2212 x 1659 pixels, color fundus photograph.
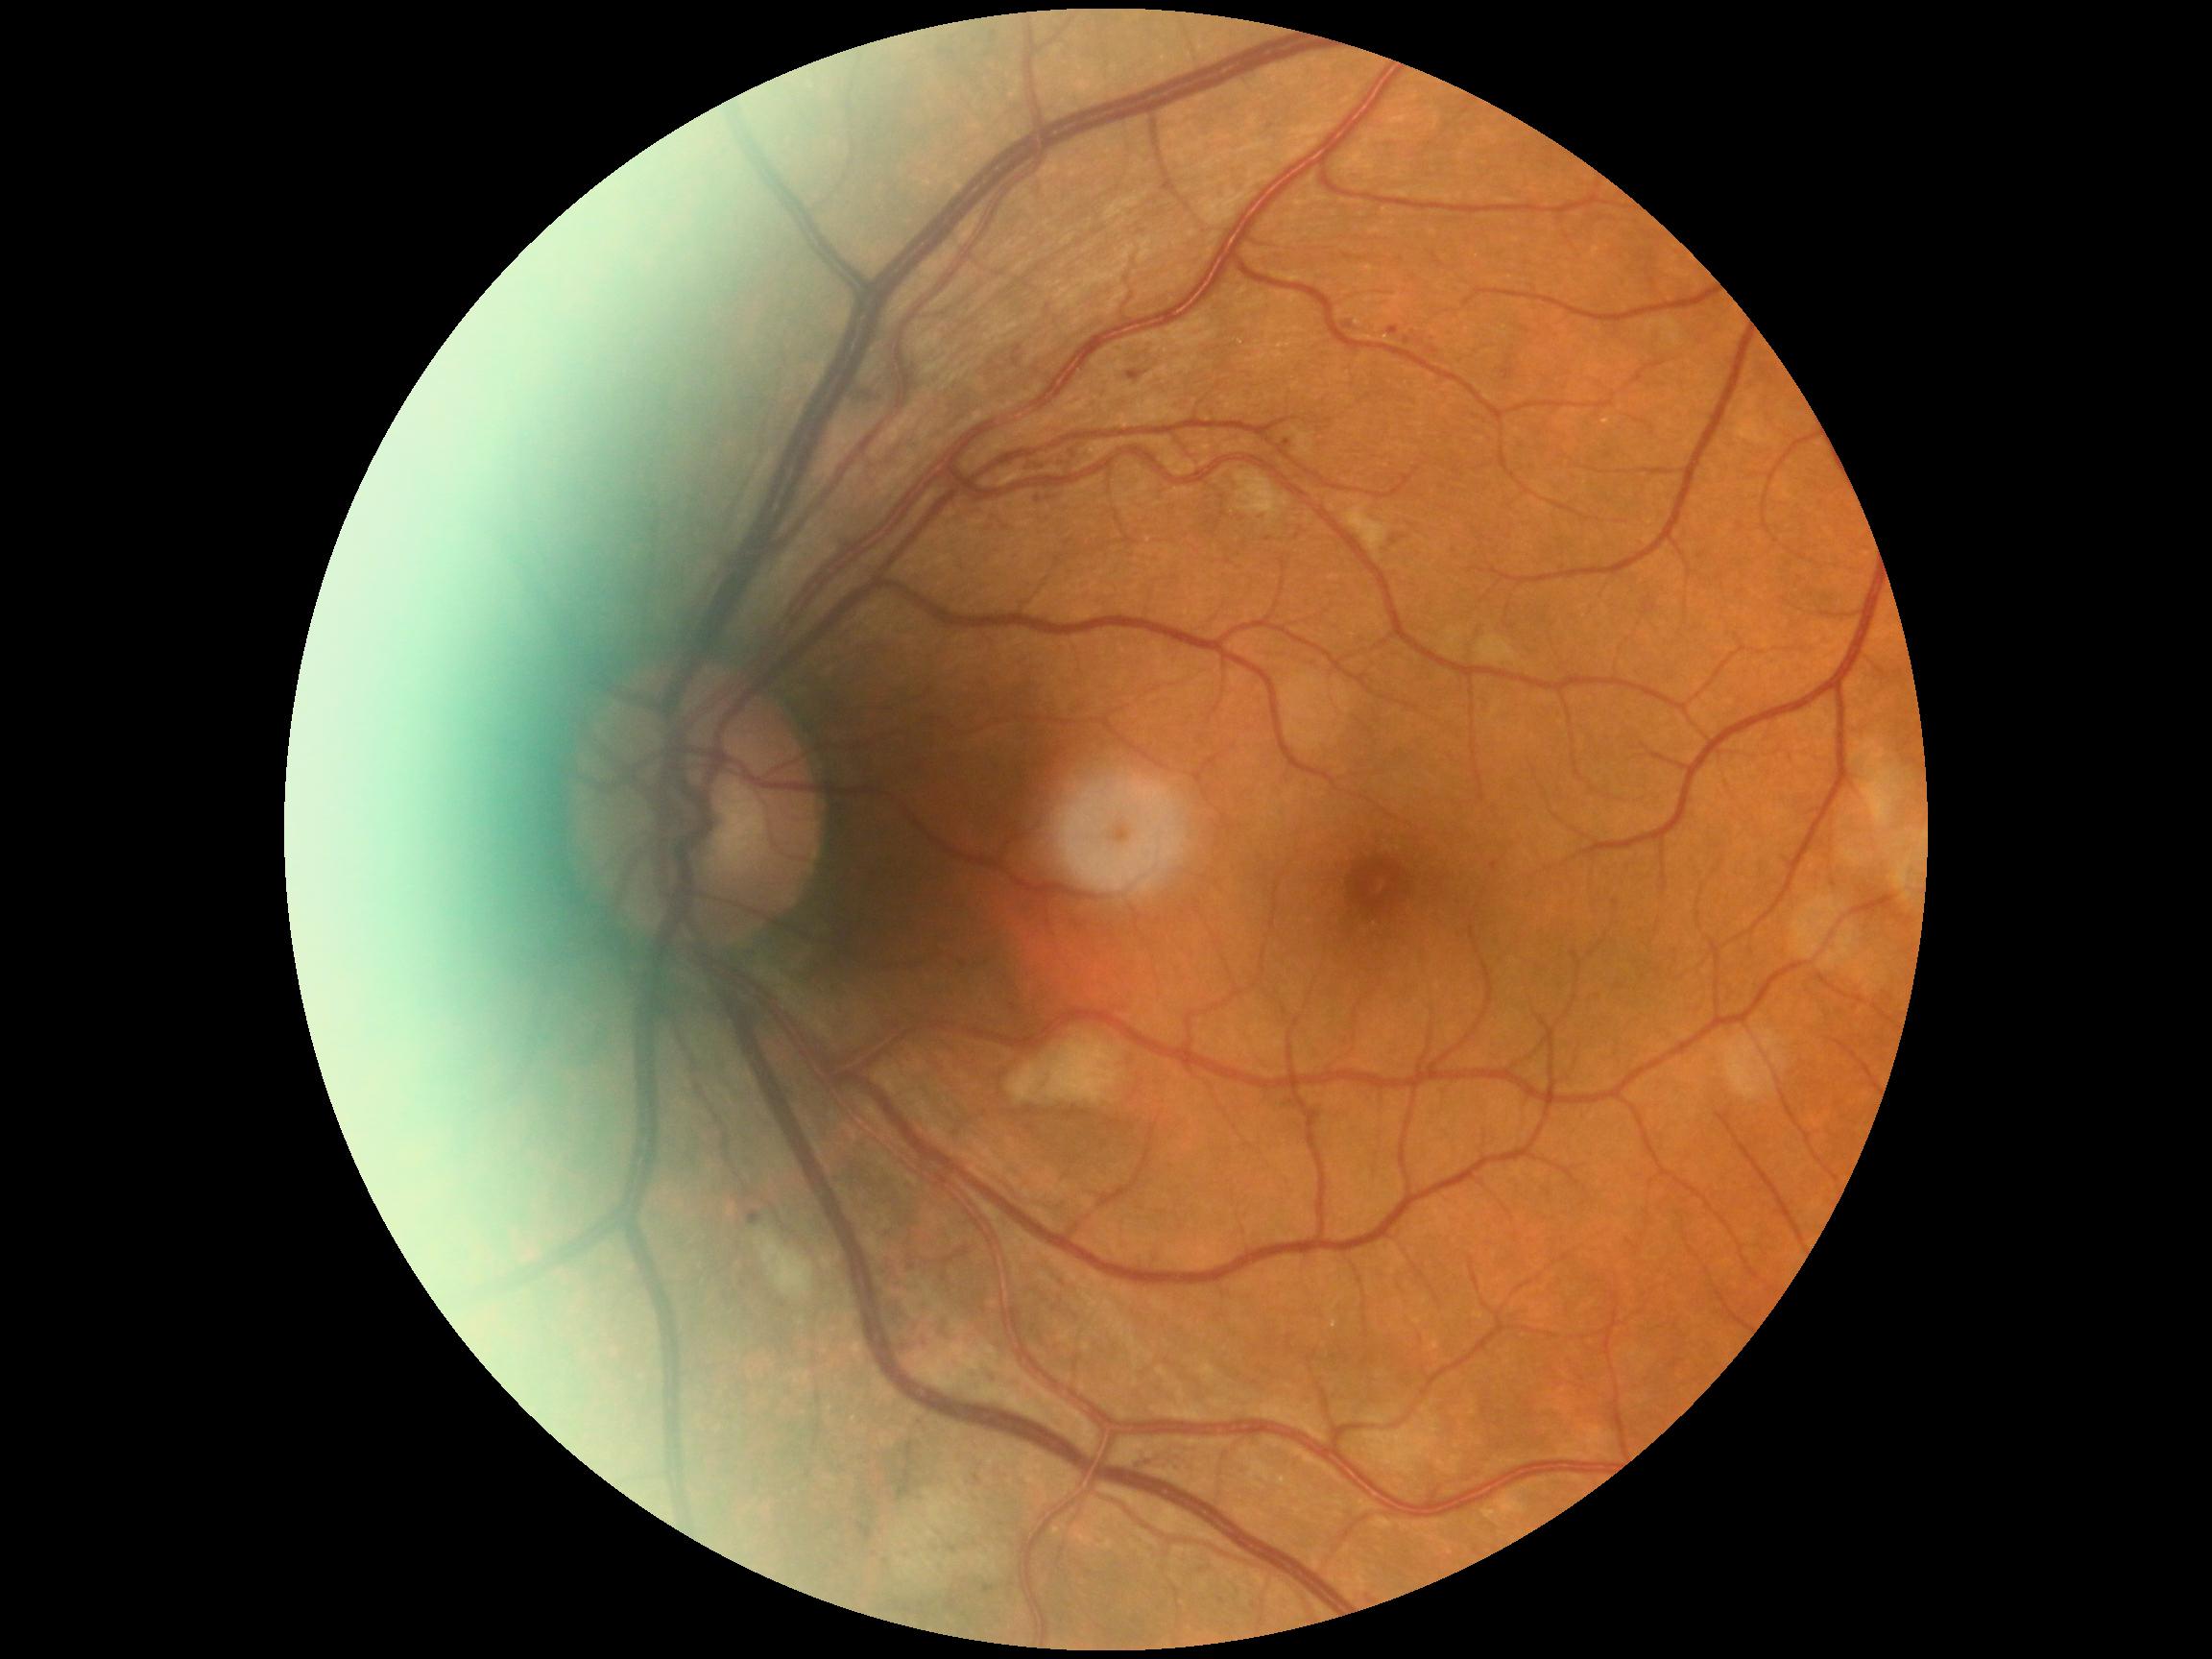
Diabetic retinopathy severity is 2.